2352x1568px — 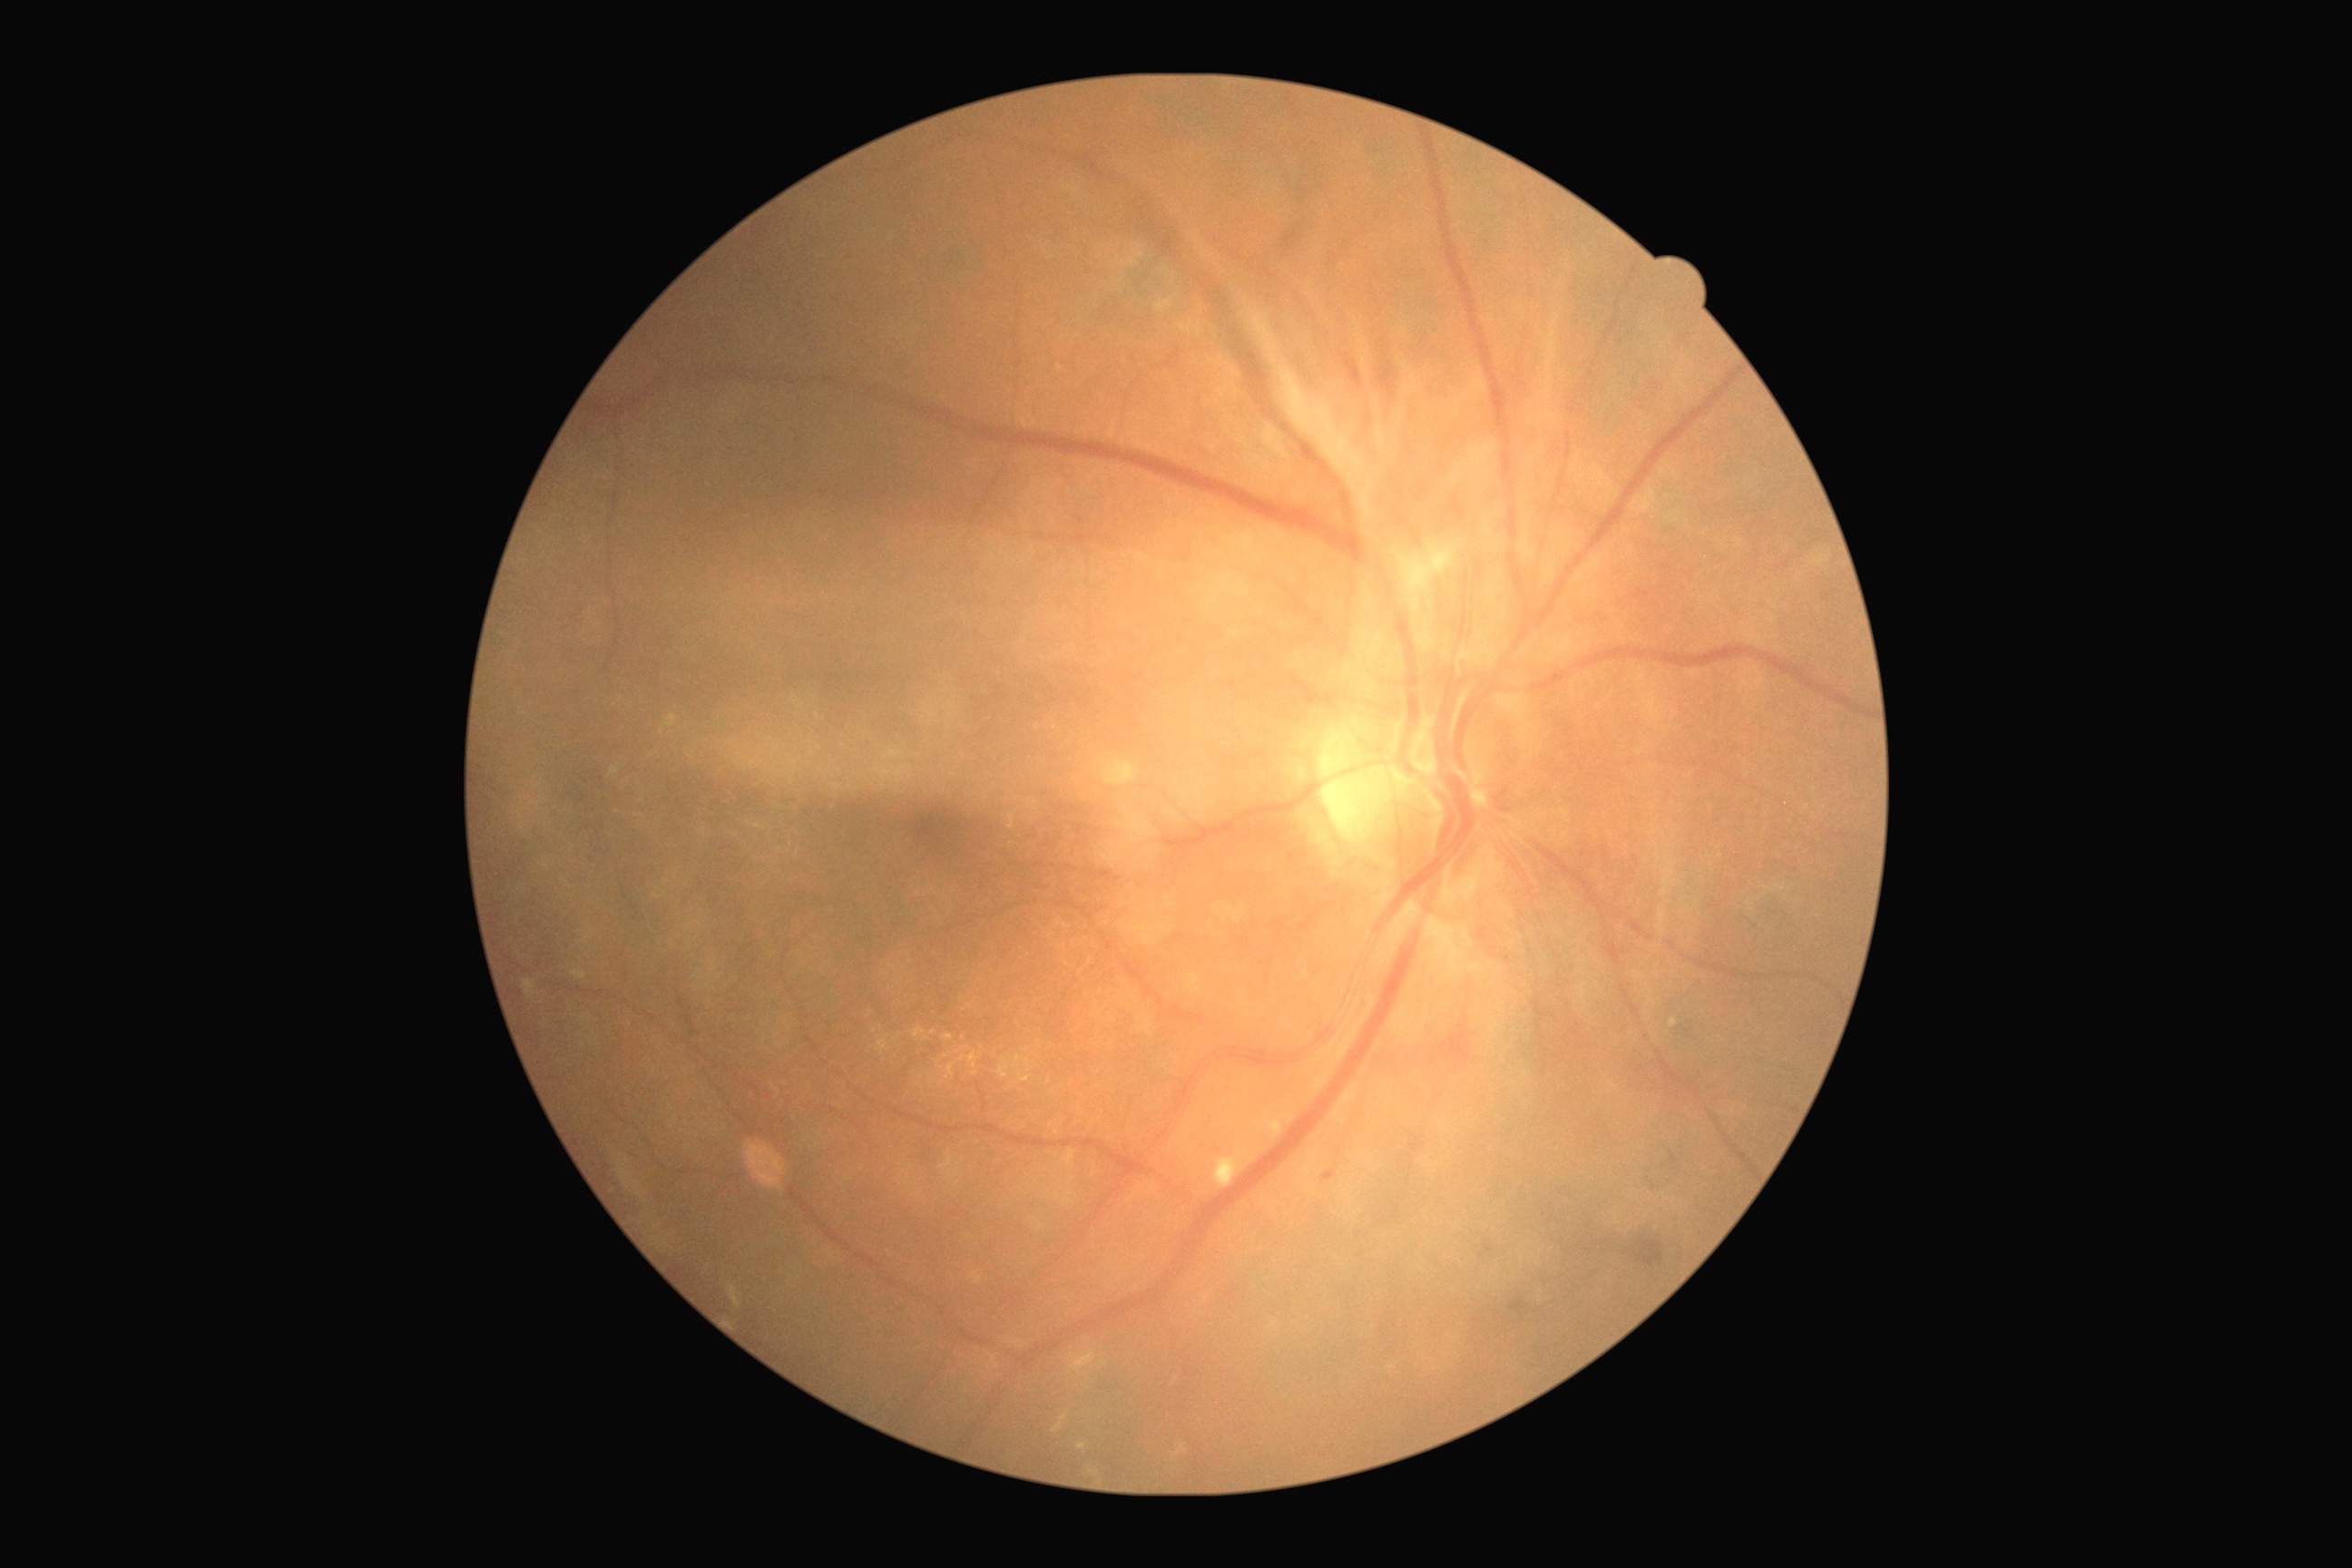

Disease class: proliferative diabetic retinopathy.
Diabetic retinopathy (DR) is PDR (grade 4) — neovascularization and/or vitreous/pre-retinal hemorrhage.